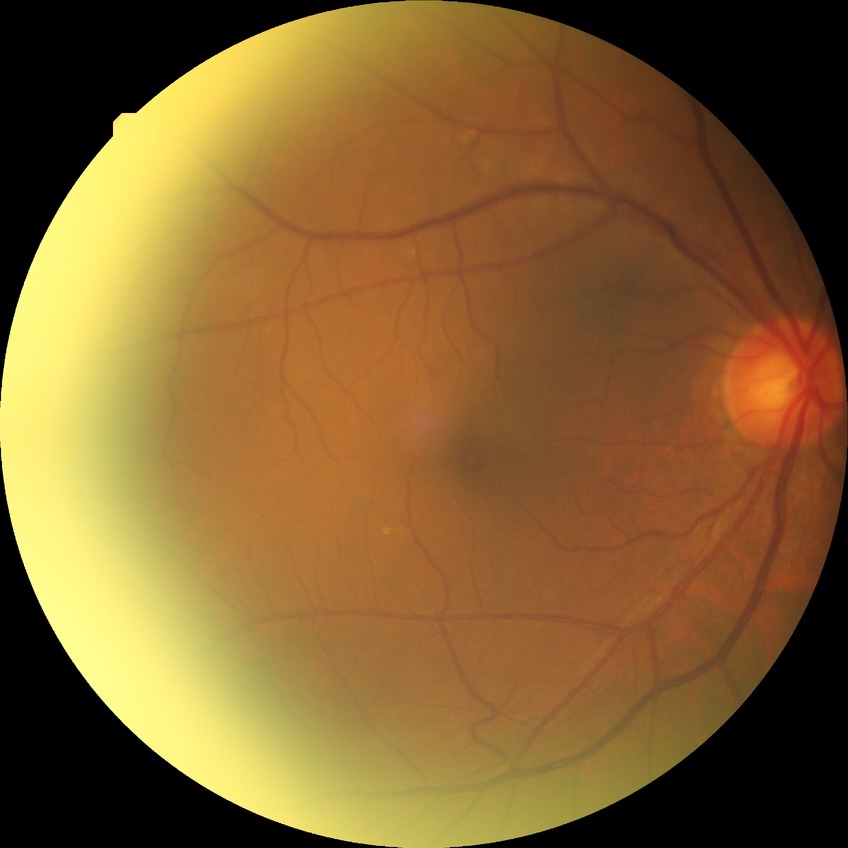

Modified Davis grading: no diabetic retinopathy.